1440 by 1080 pixels · pediatric retinal photograph (wide-field).
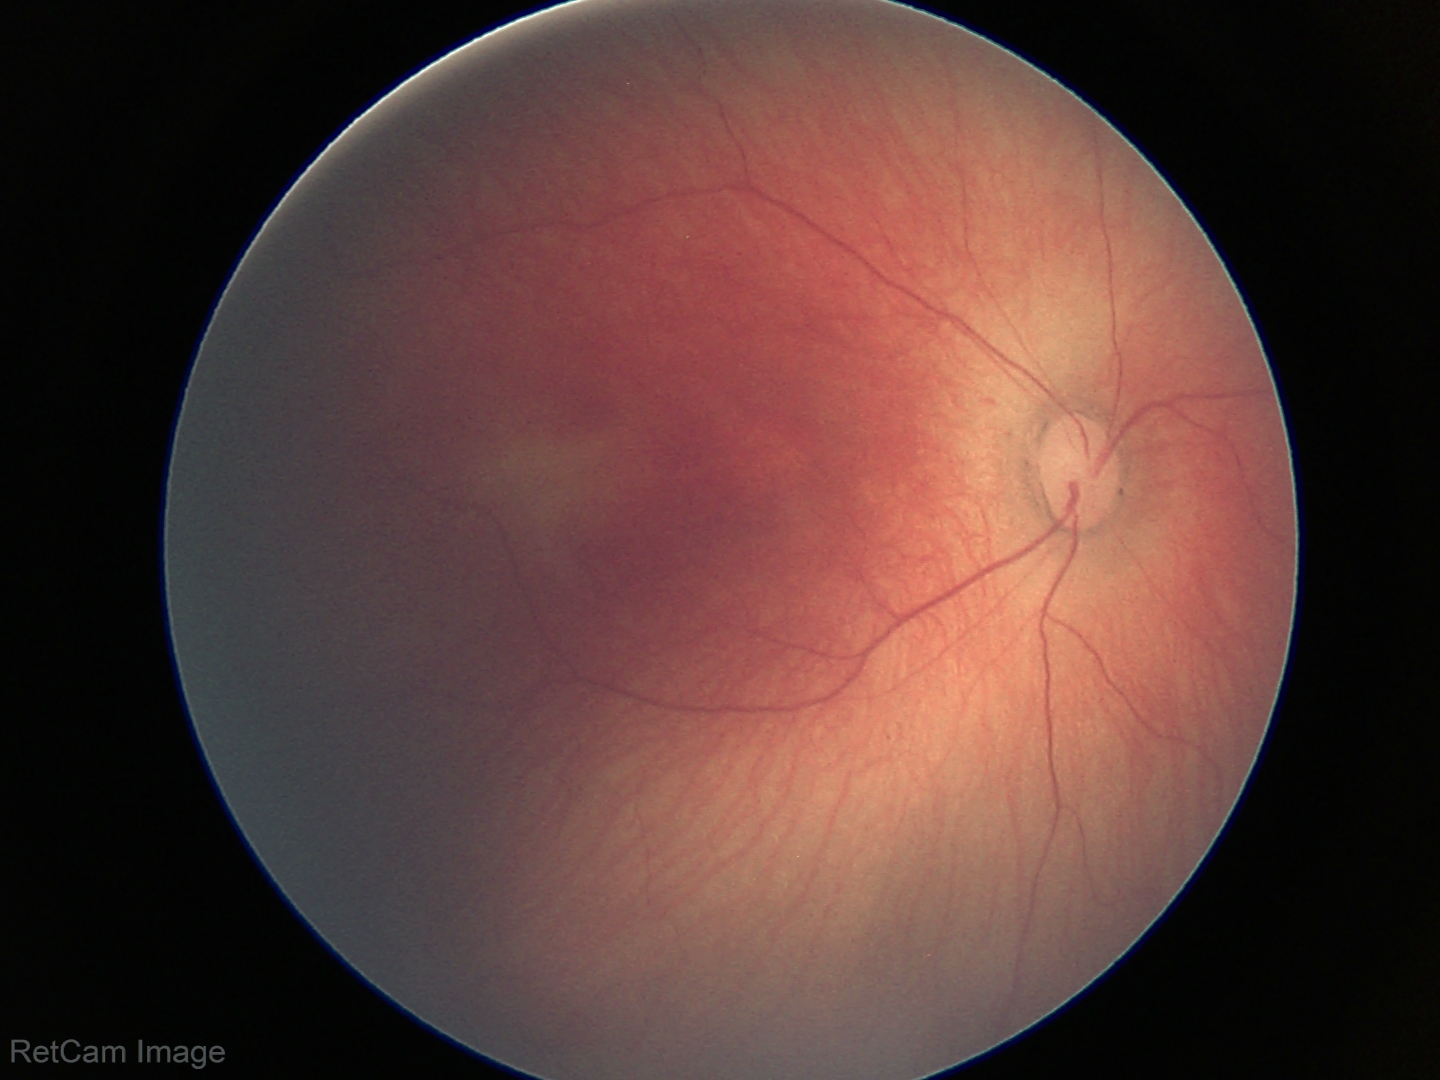
Assessment: retinopathy of prematurity stage 1.